IOP by Perkins applanation tonometry: 28 mmHg
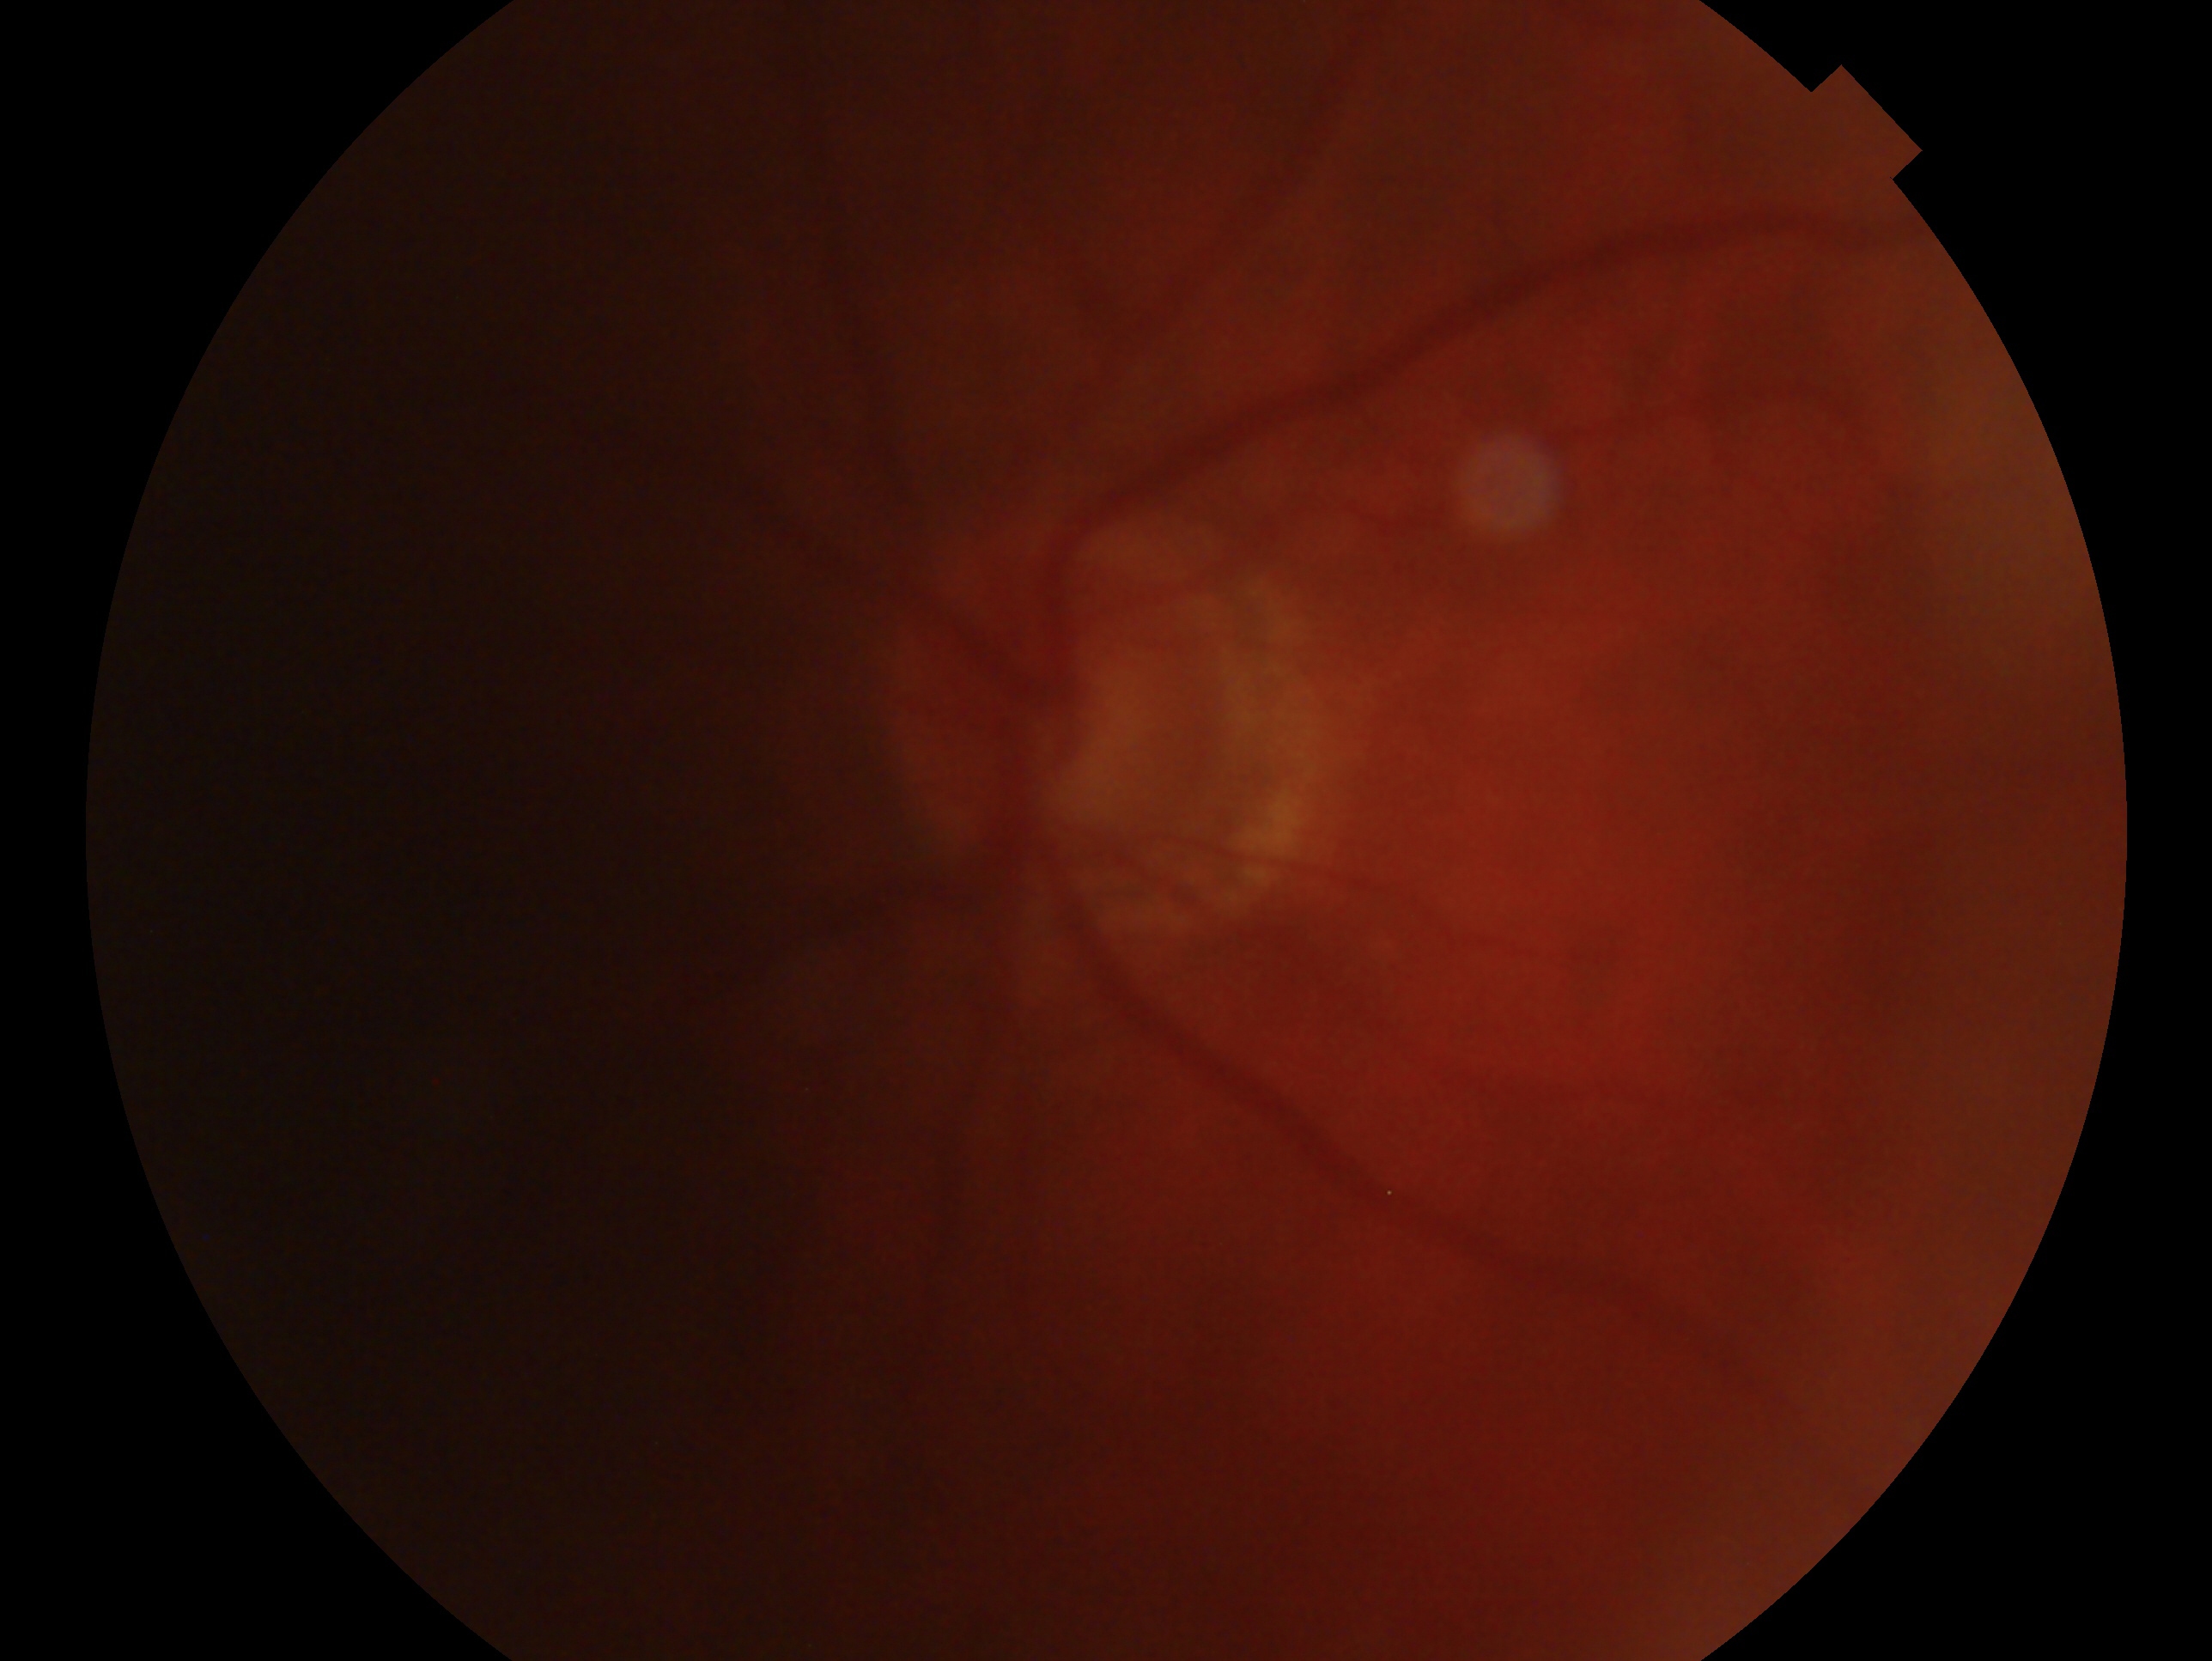

clinical classification = glaucomatous optic neuropathy; laterality = oculus sinister.